Wide-field fundus photograph of an infant: 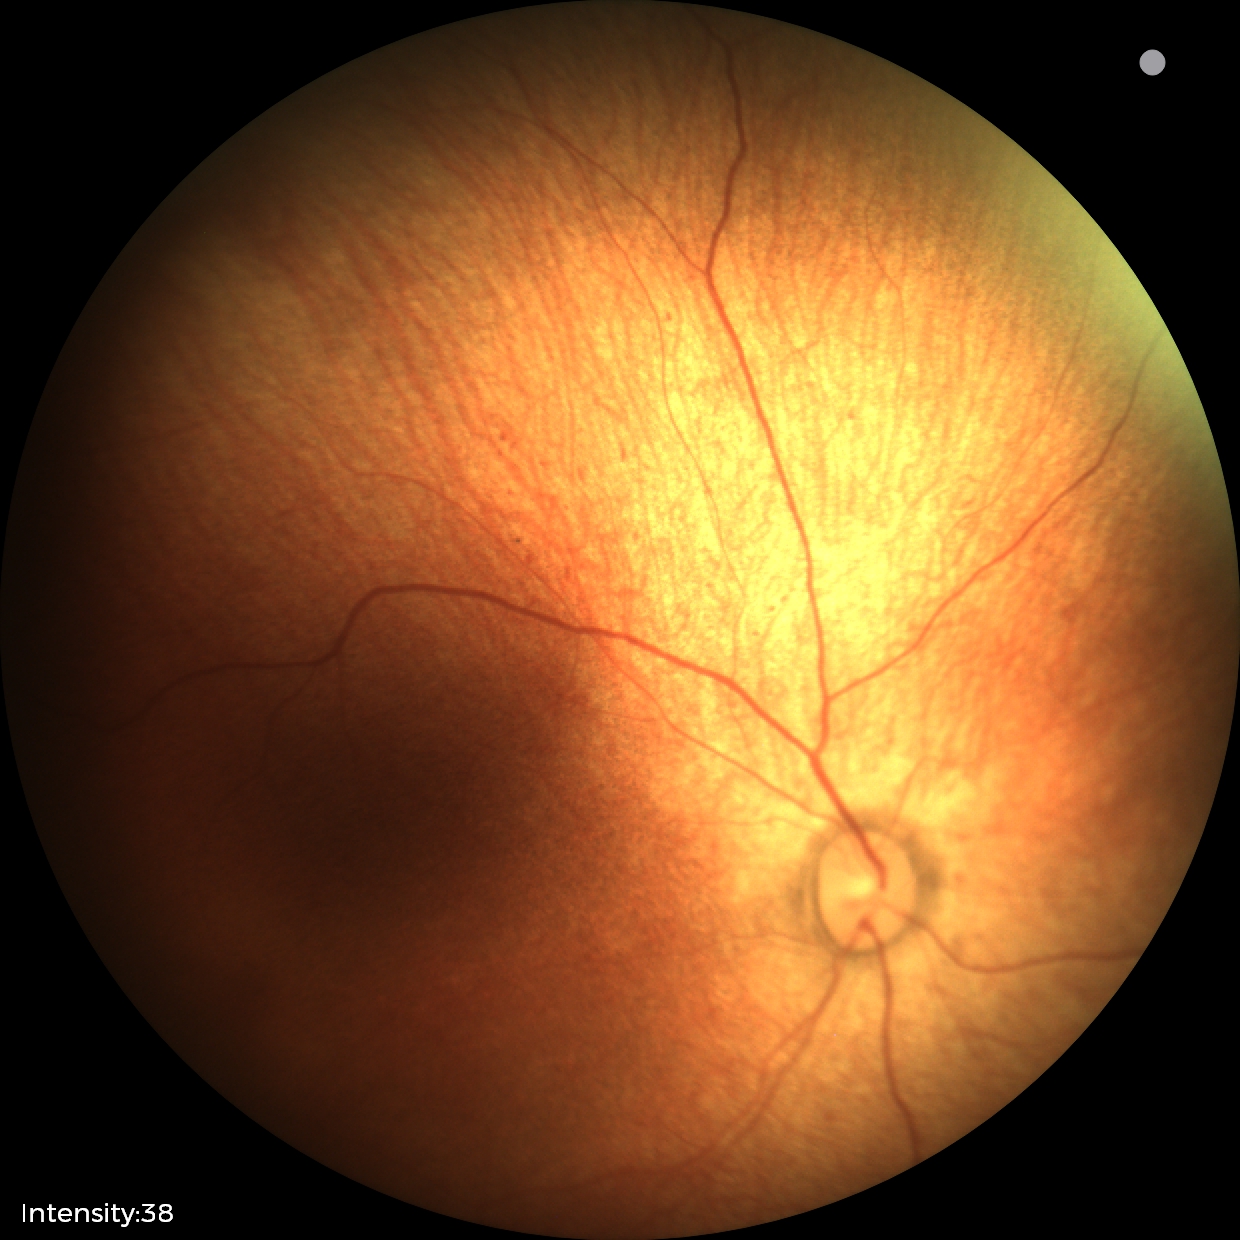
Screening examination diagnosed as physiological.